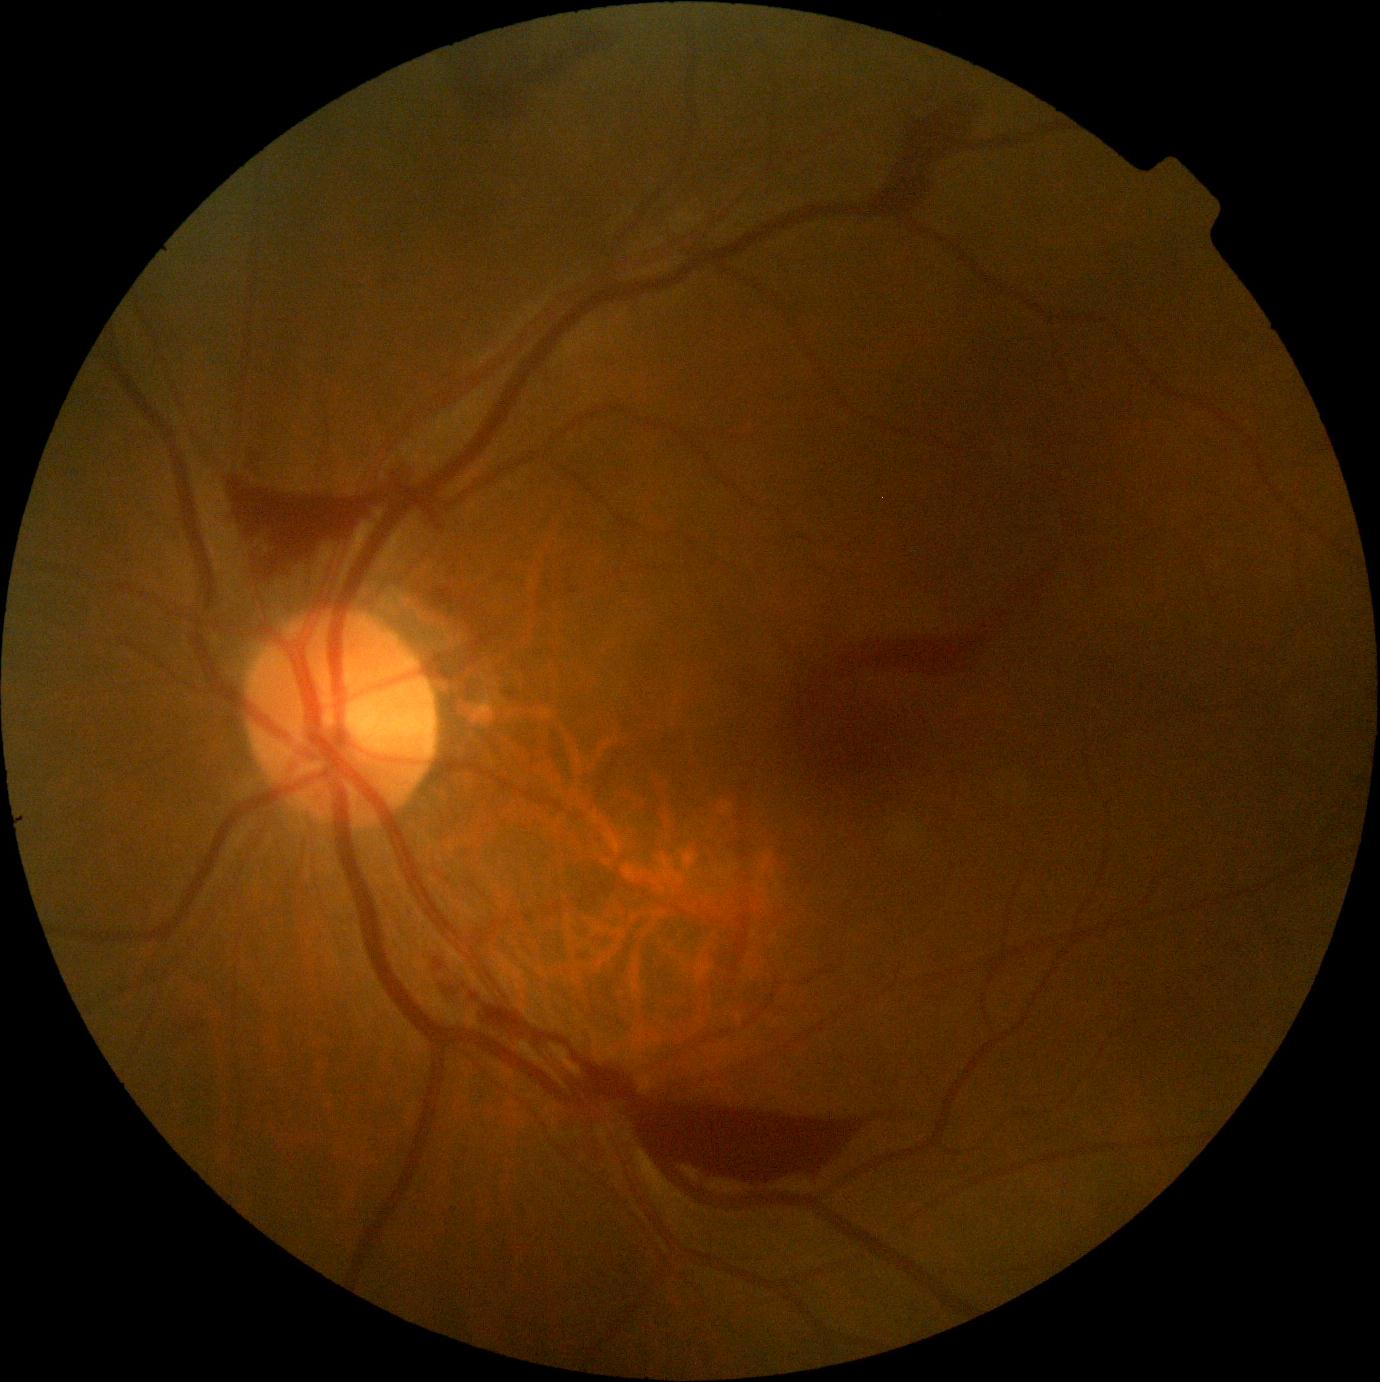 Diabetic retinopathy: grade 4 (PDR). Disease class: proliferative diabetic retinopathy.